Acquired with a Topcon TRC-50DX · mydriatic (tropicamide and phenylephrine) · 2228 x 1652 pixels · posterior pole field covering the optic disc and macula: 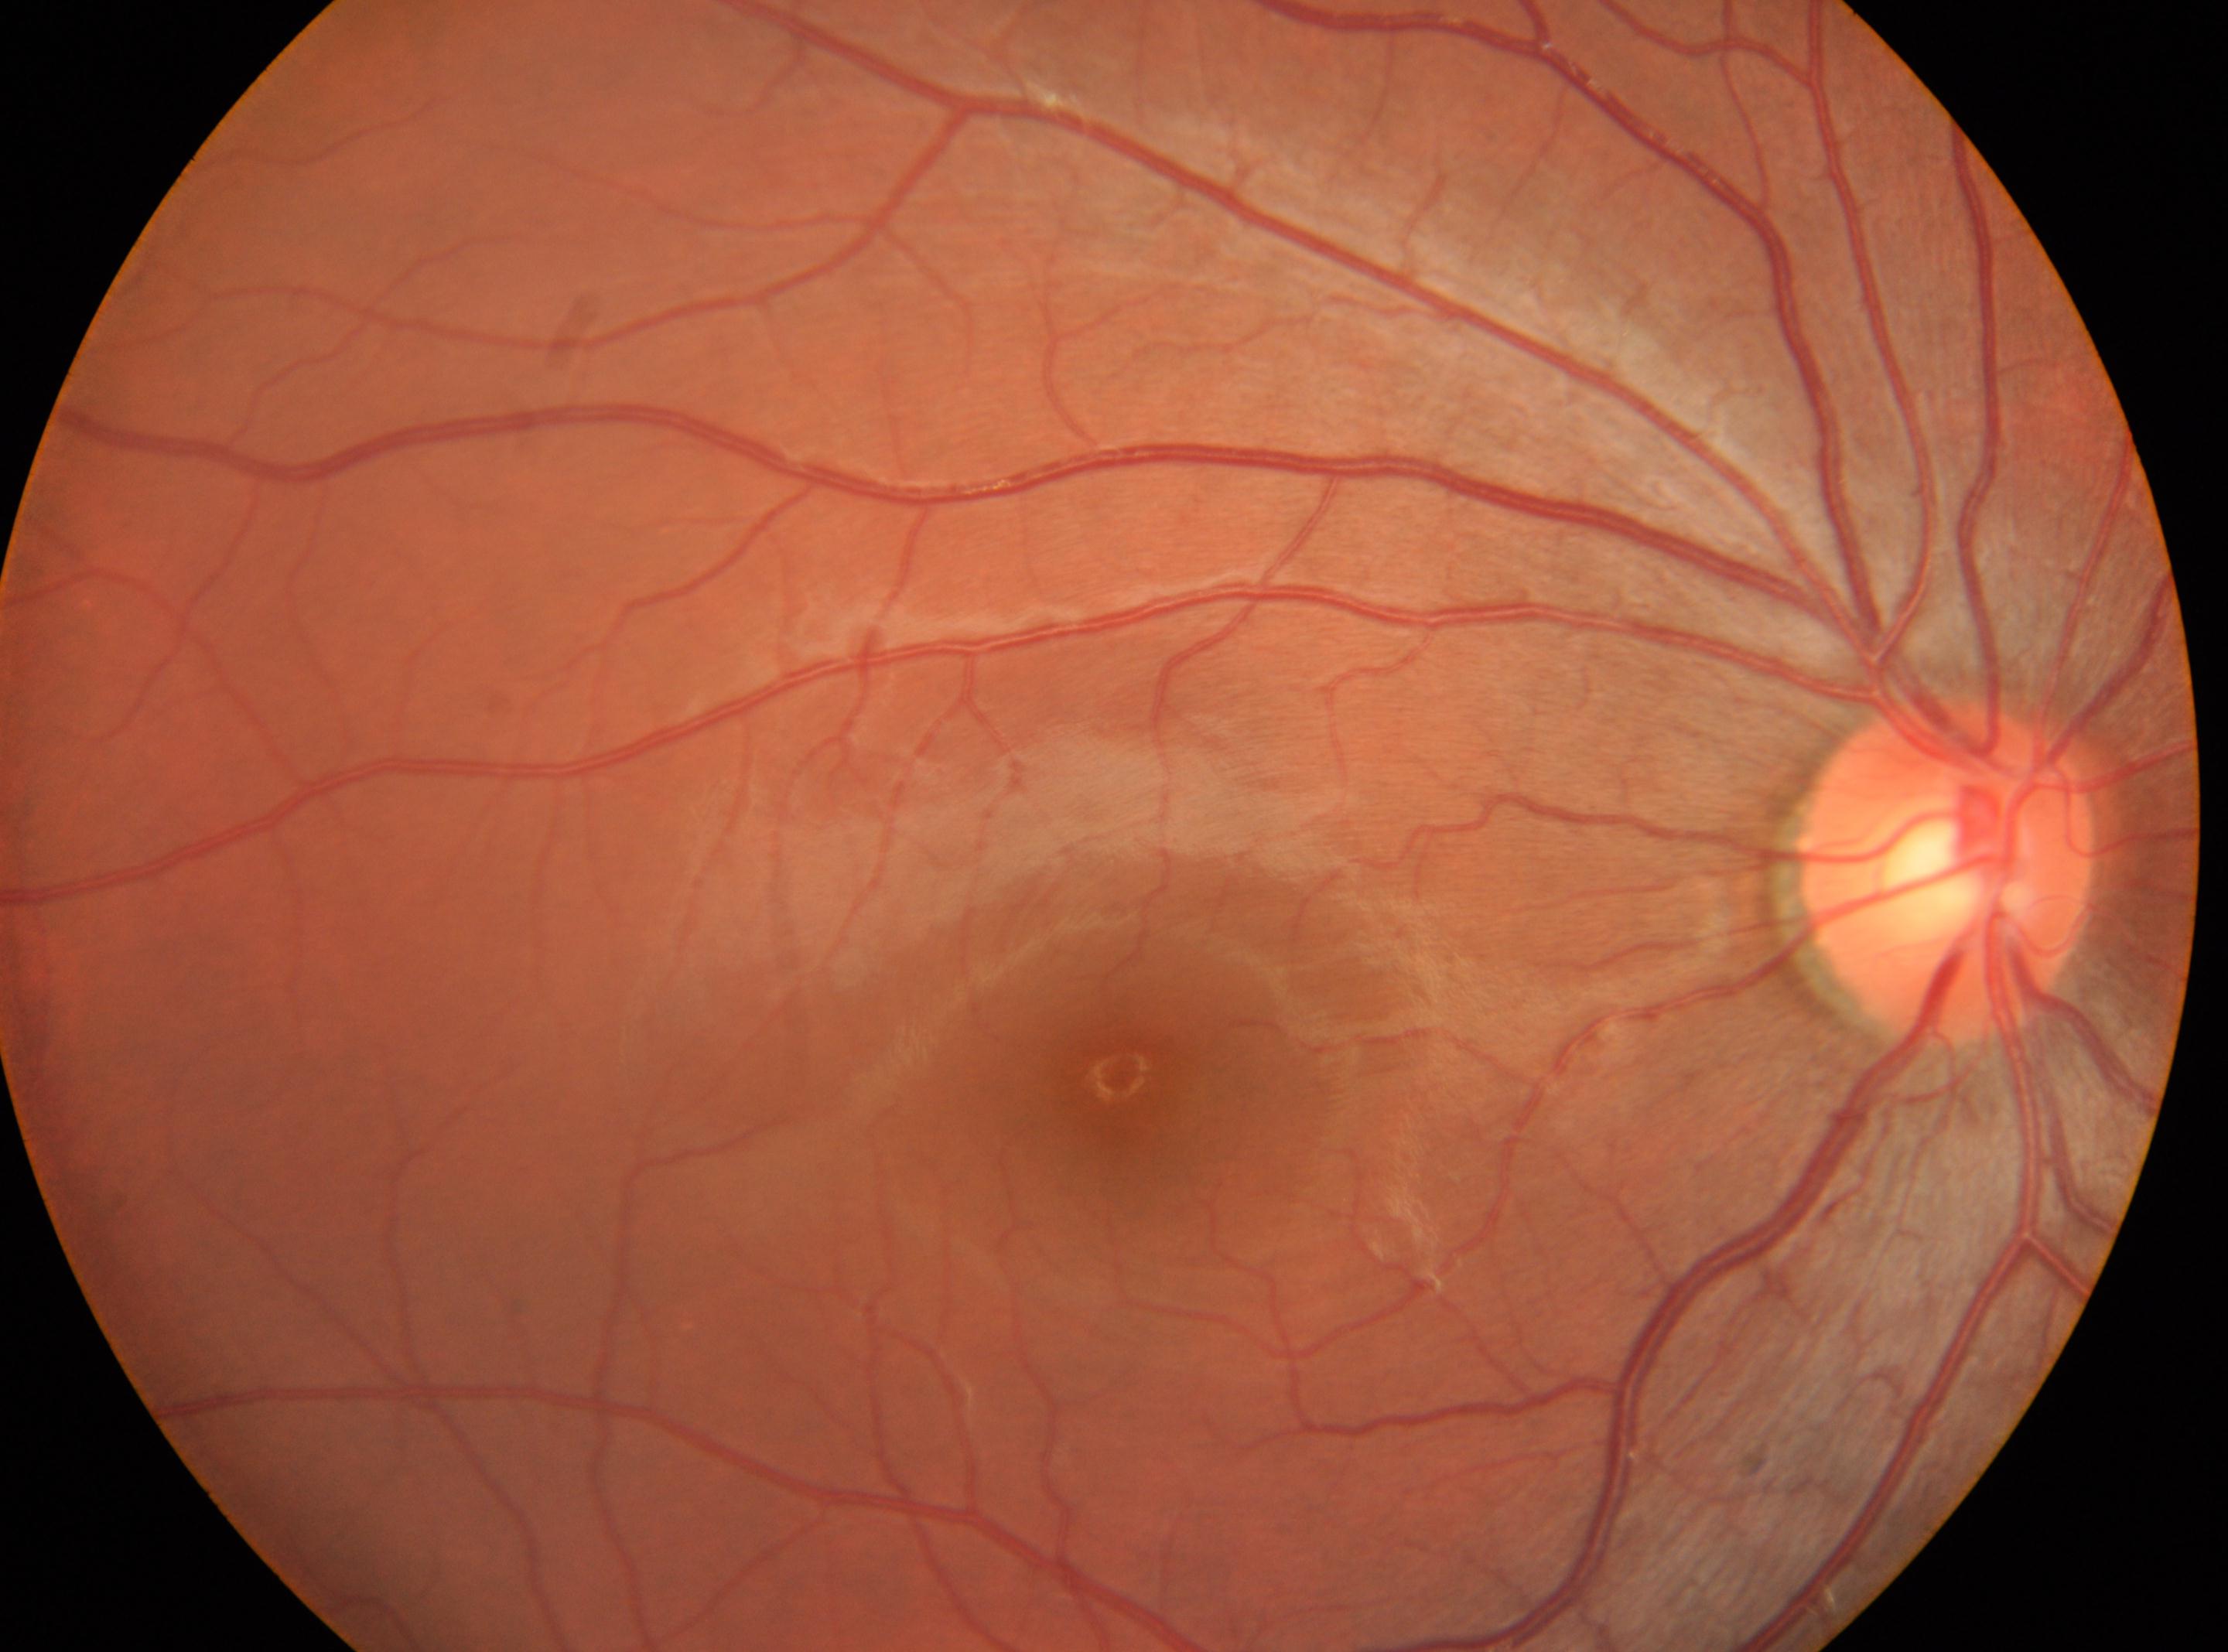

The foveal center is at 1120, 1073. Optic disc: 1946, 869. The image shows the right eye. No diabetic retinal disease findings. DR grade is no apparent diabetic retinopathy (0).